Wide-field fundus photograph of an infant:
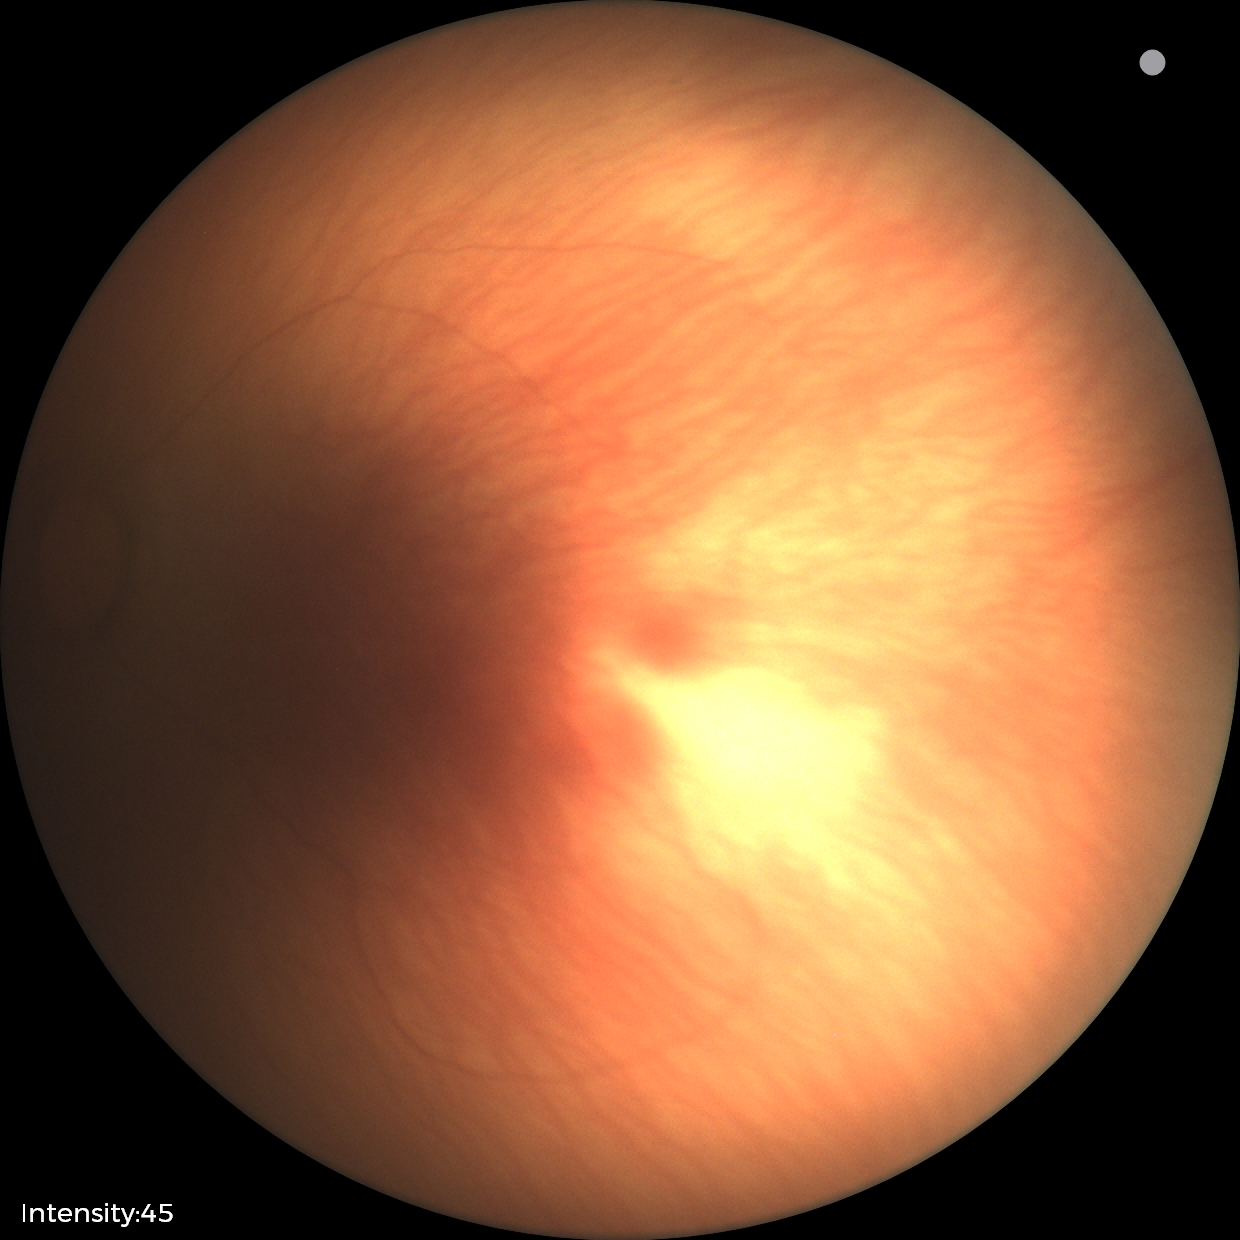
Impression: physiological finding.